45° FOV. 2352 by 1568 pixels
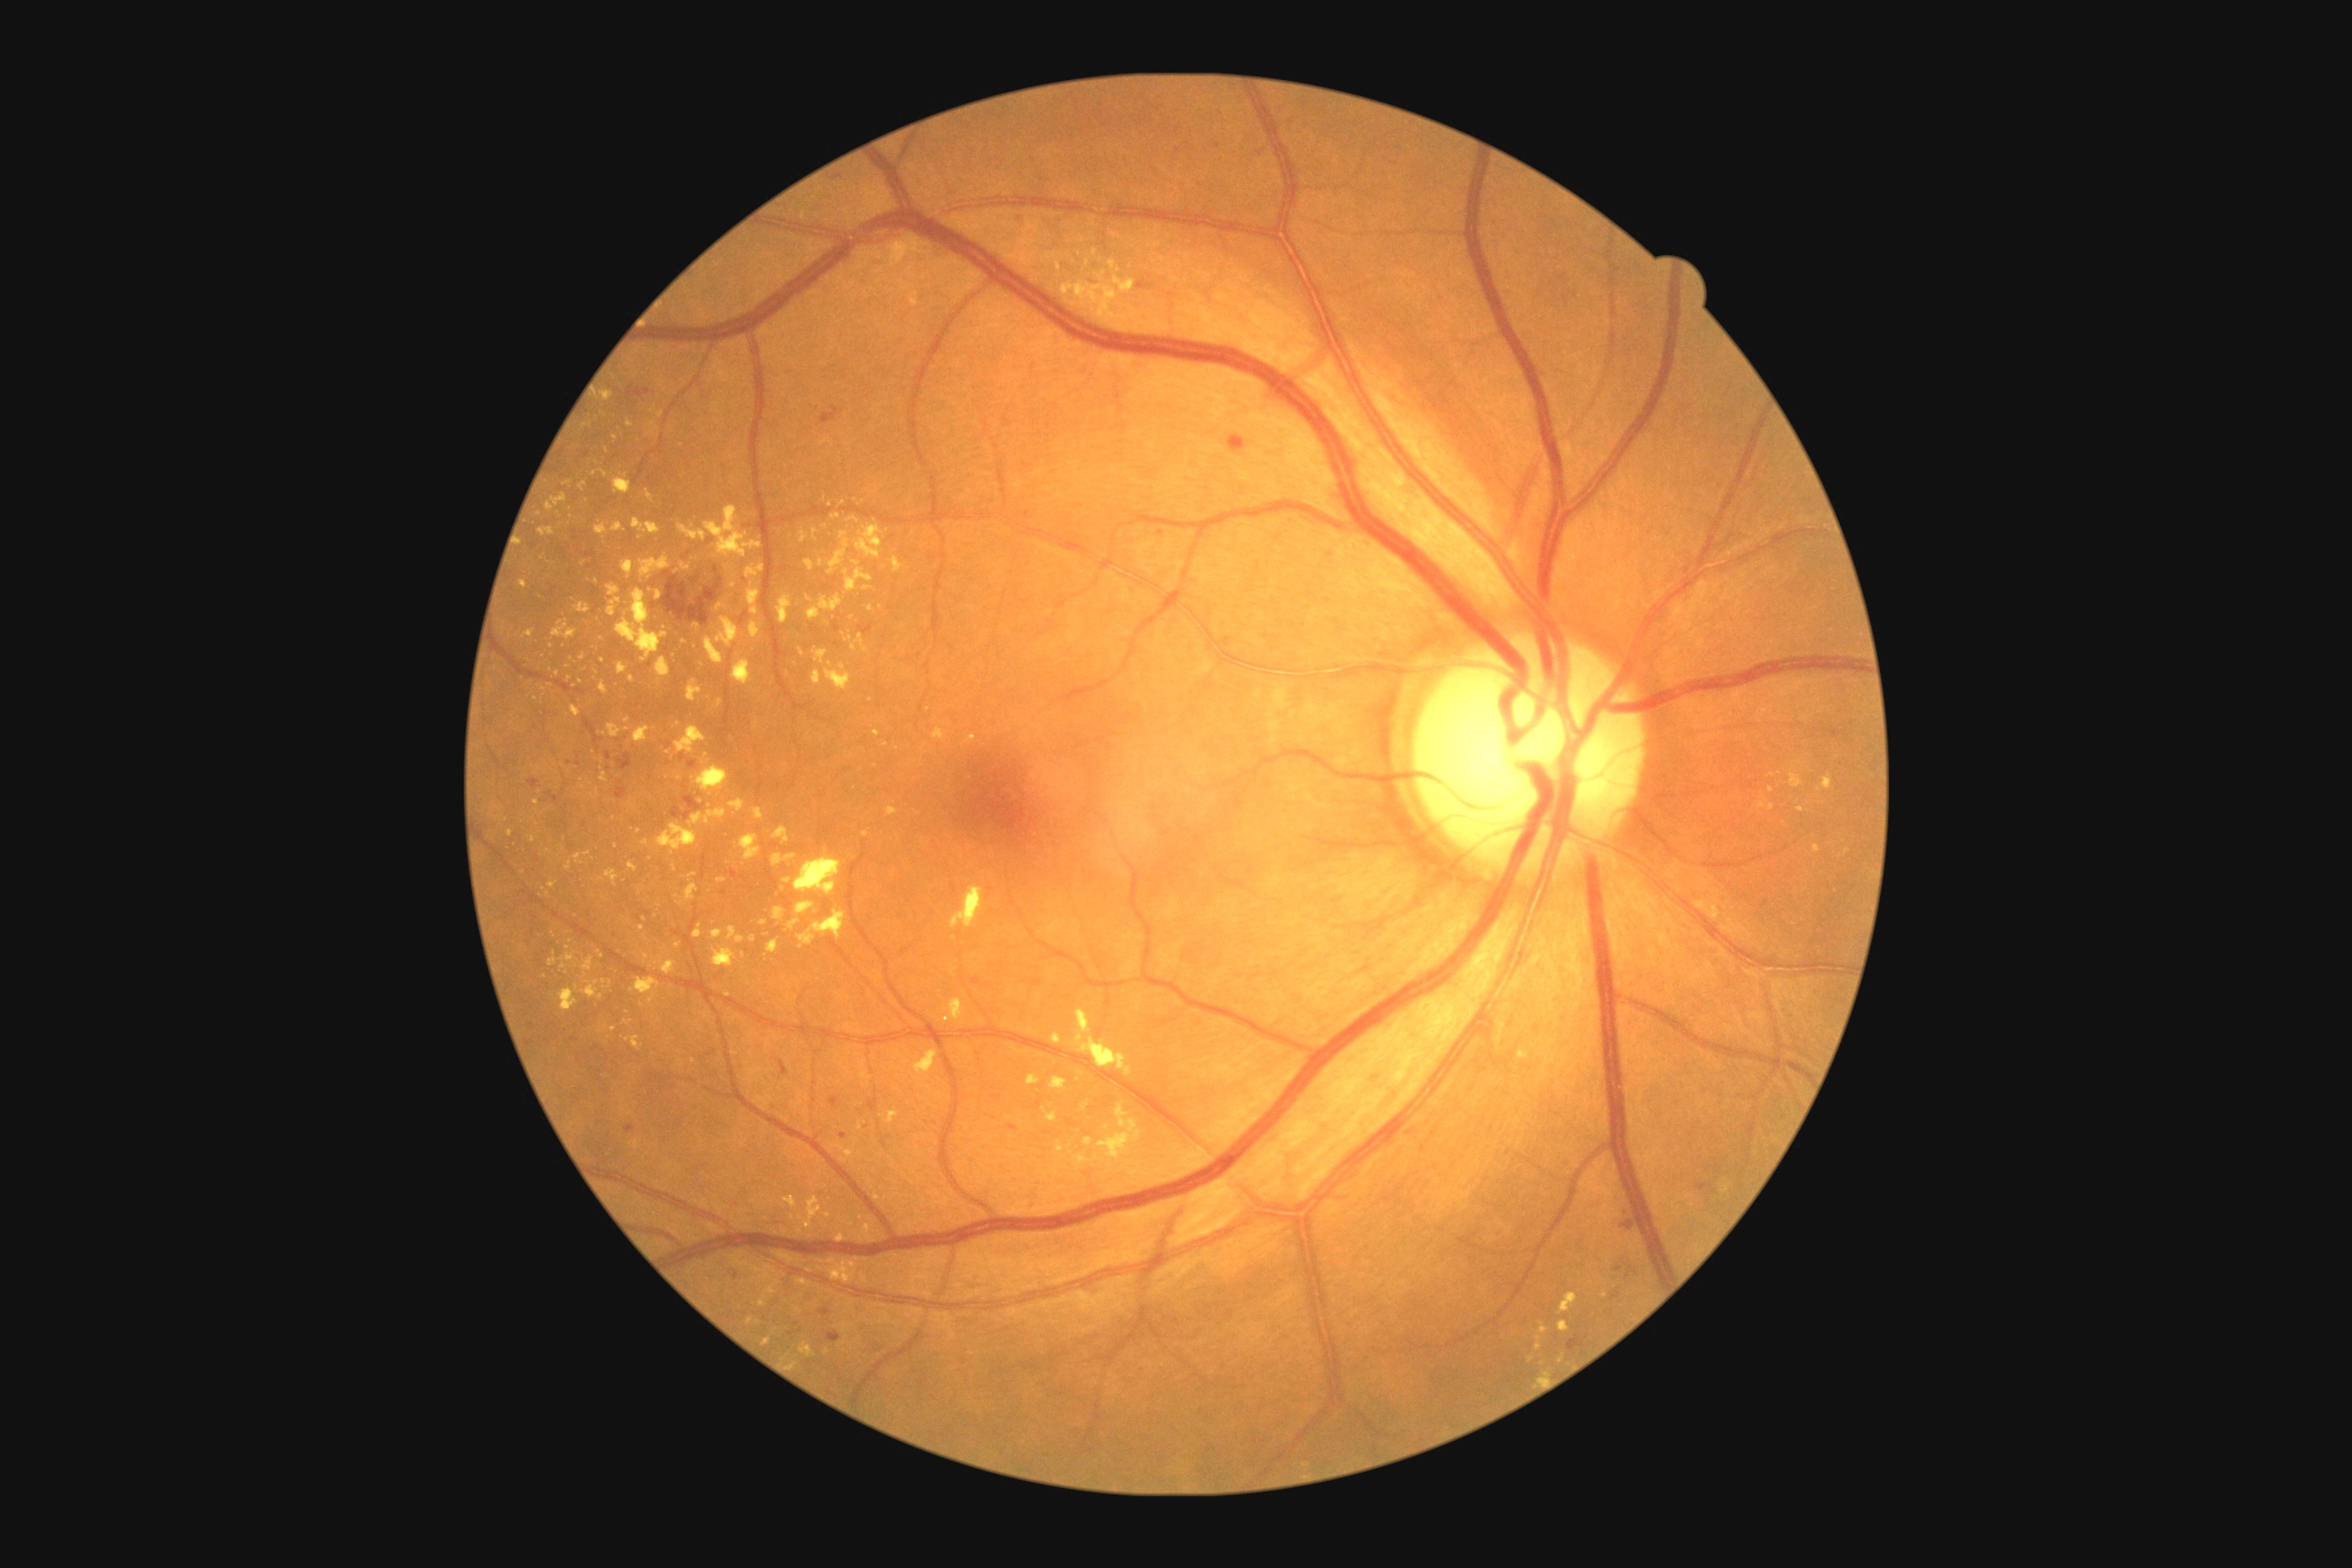 <lesions partial="true">
  <dr_grade>2</dr_grade>
  <ex partial="true">894/558/903/573 | 716/616/740/649 | 549/881/556/890 | 888/807/897/818 | 631/520/660/534 | 1043/1108/1057/1122 | 656/658/671/678 | 576/603/591/614 | 912/297/917/308 | 616/589/669/663</ex>
  <ex_small_centers><point>881, 607</point> | <point>826, 1352</point> | <point>809, 600</point> | <point>881, 1269</point> | <point>736, 1019</point> | <point>677, 945</point> | <point>537, 804</point> | <point>1772, 808</point> | <point>594, 474</point></ex_small_centers>
</lesions>